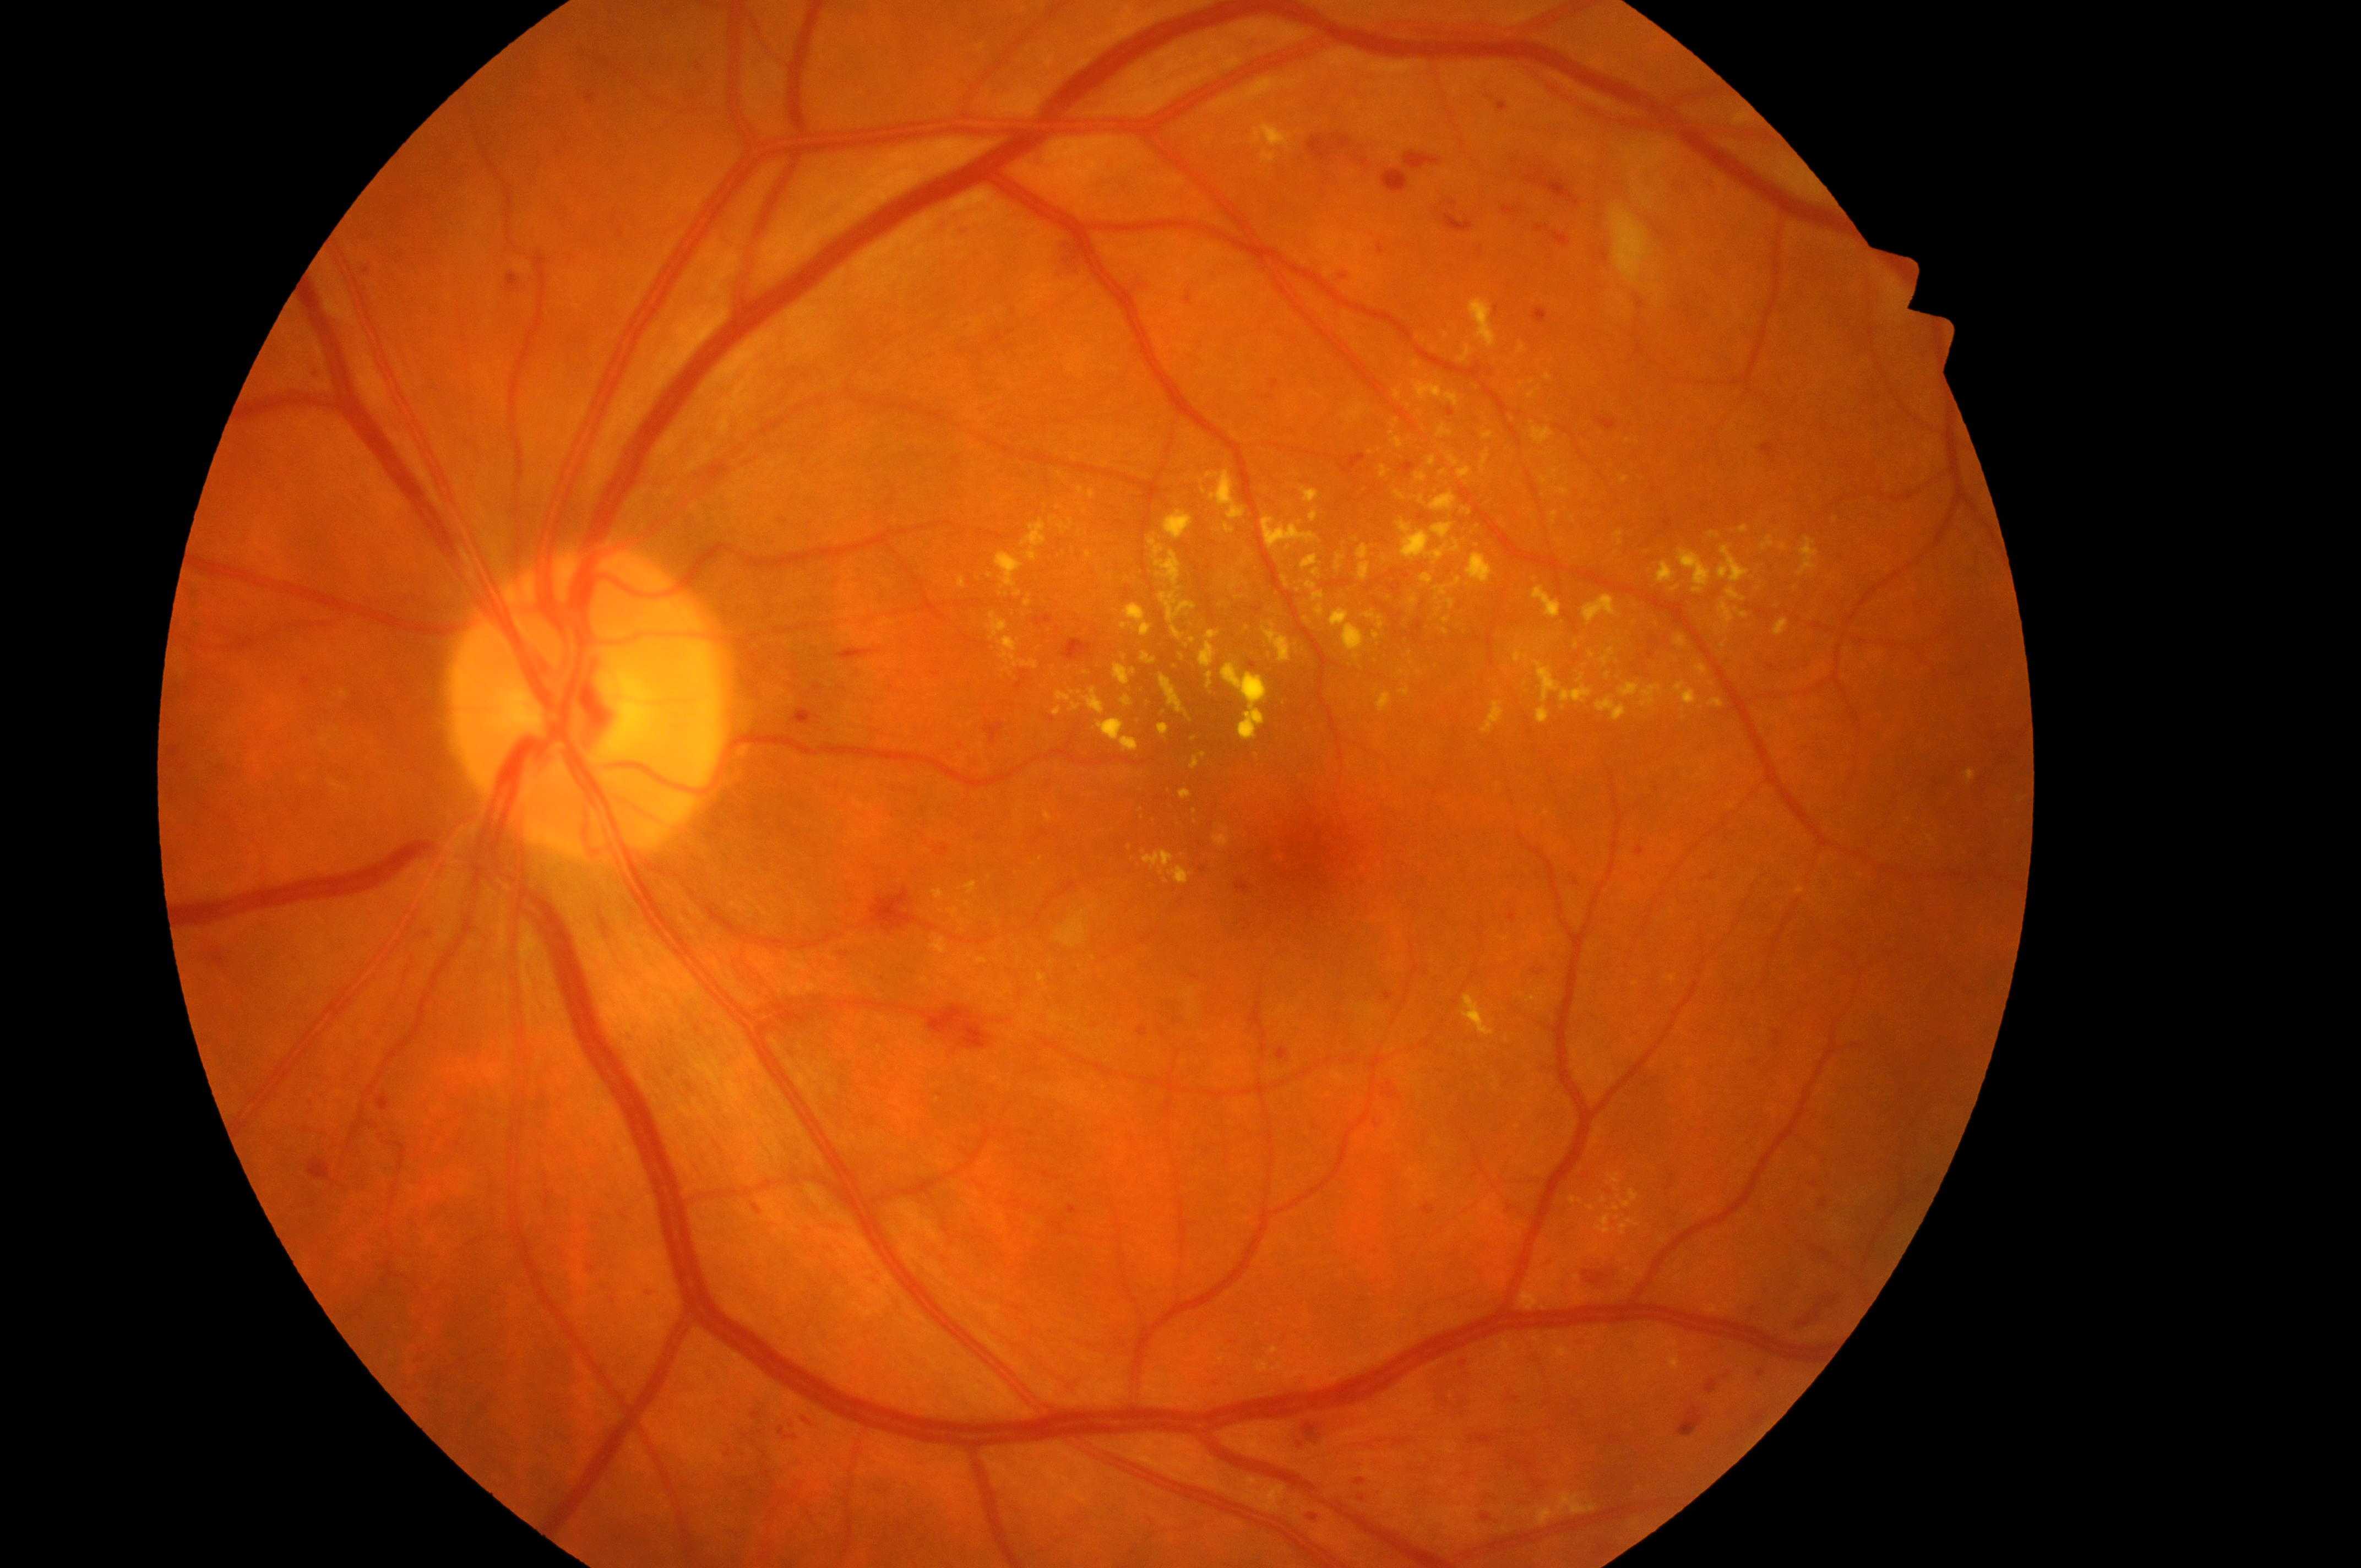
The image shows the OS.
Diabetic retinopathy grade: moderate non-proliferative diabetic retinopathy (2).
Macular edema risk: high risk (grade 2).
Optic disk: x=581, y=709.
The macular center is at x=1305, y=839.
The retinopathy is classified as non-proliferative diabetic retinopathy.